Wide-field fundus photograph from neonatal ROP screening.
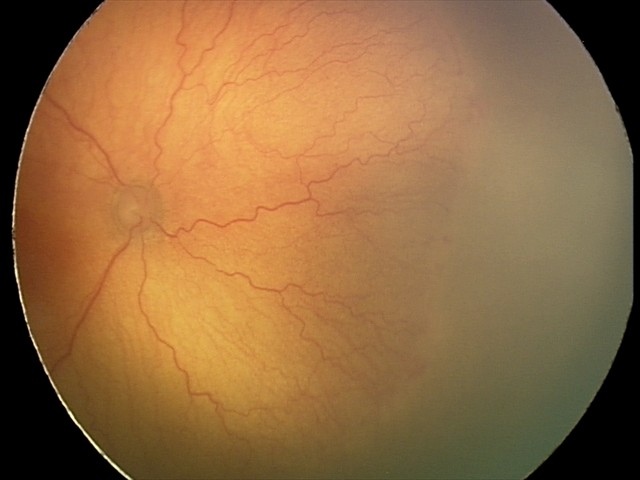

Assessment: plus disease; A-ROP (aggressive ROP).